Wide-field contact fundus photograph of an infant: 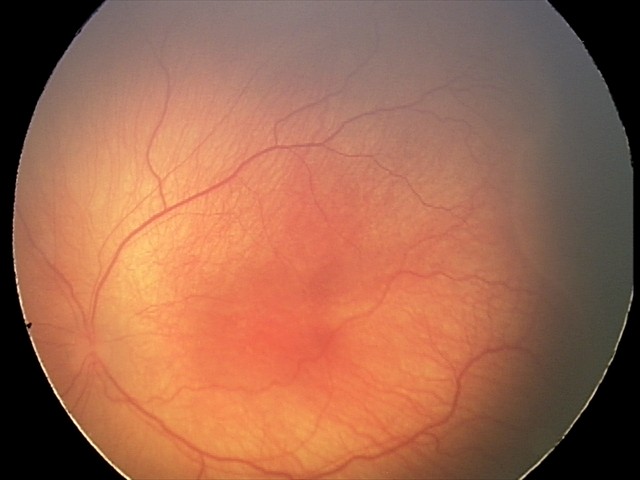 Q: What is the screening diagnosis?
A: ROP stage 2
Q: Is plus disease present?
A: no plus disease — posterior pole vessels without abnormal dilation or tortuosity